Image size 2212x1659 — 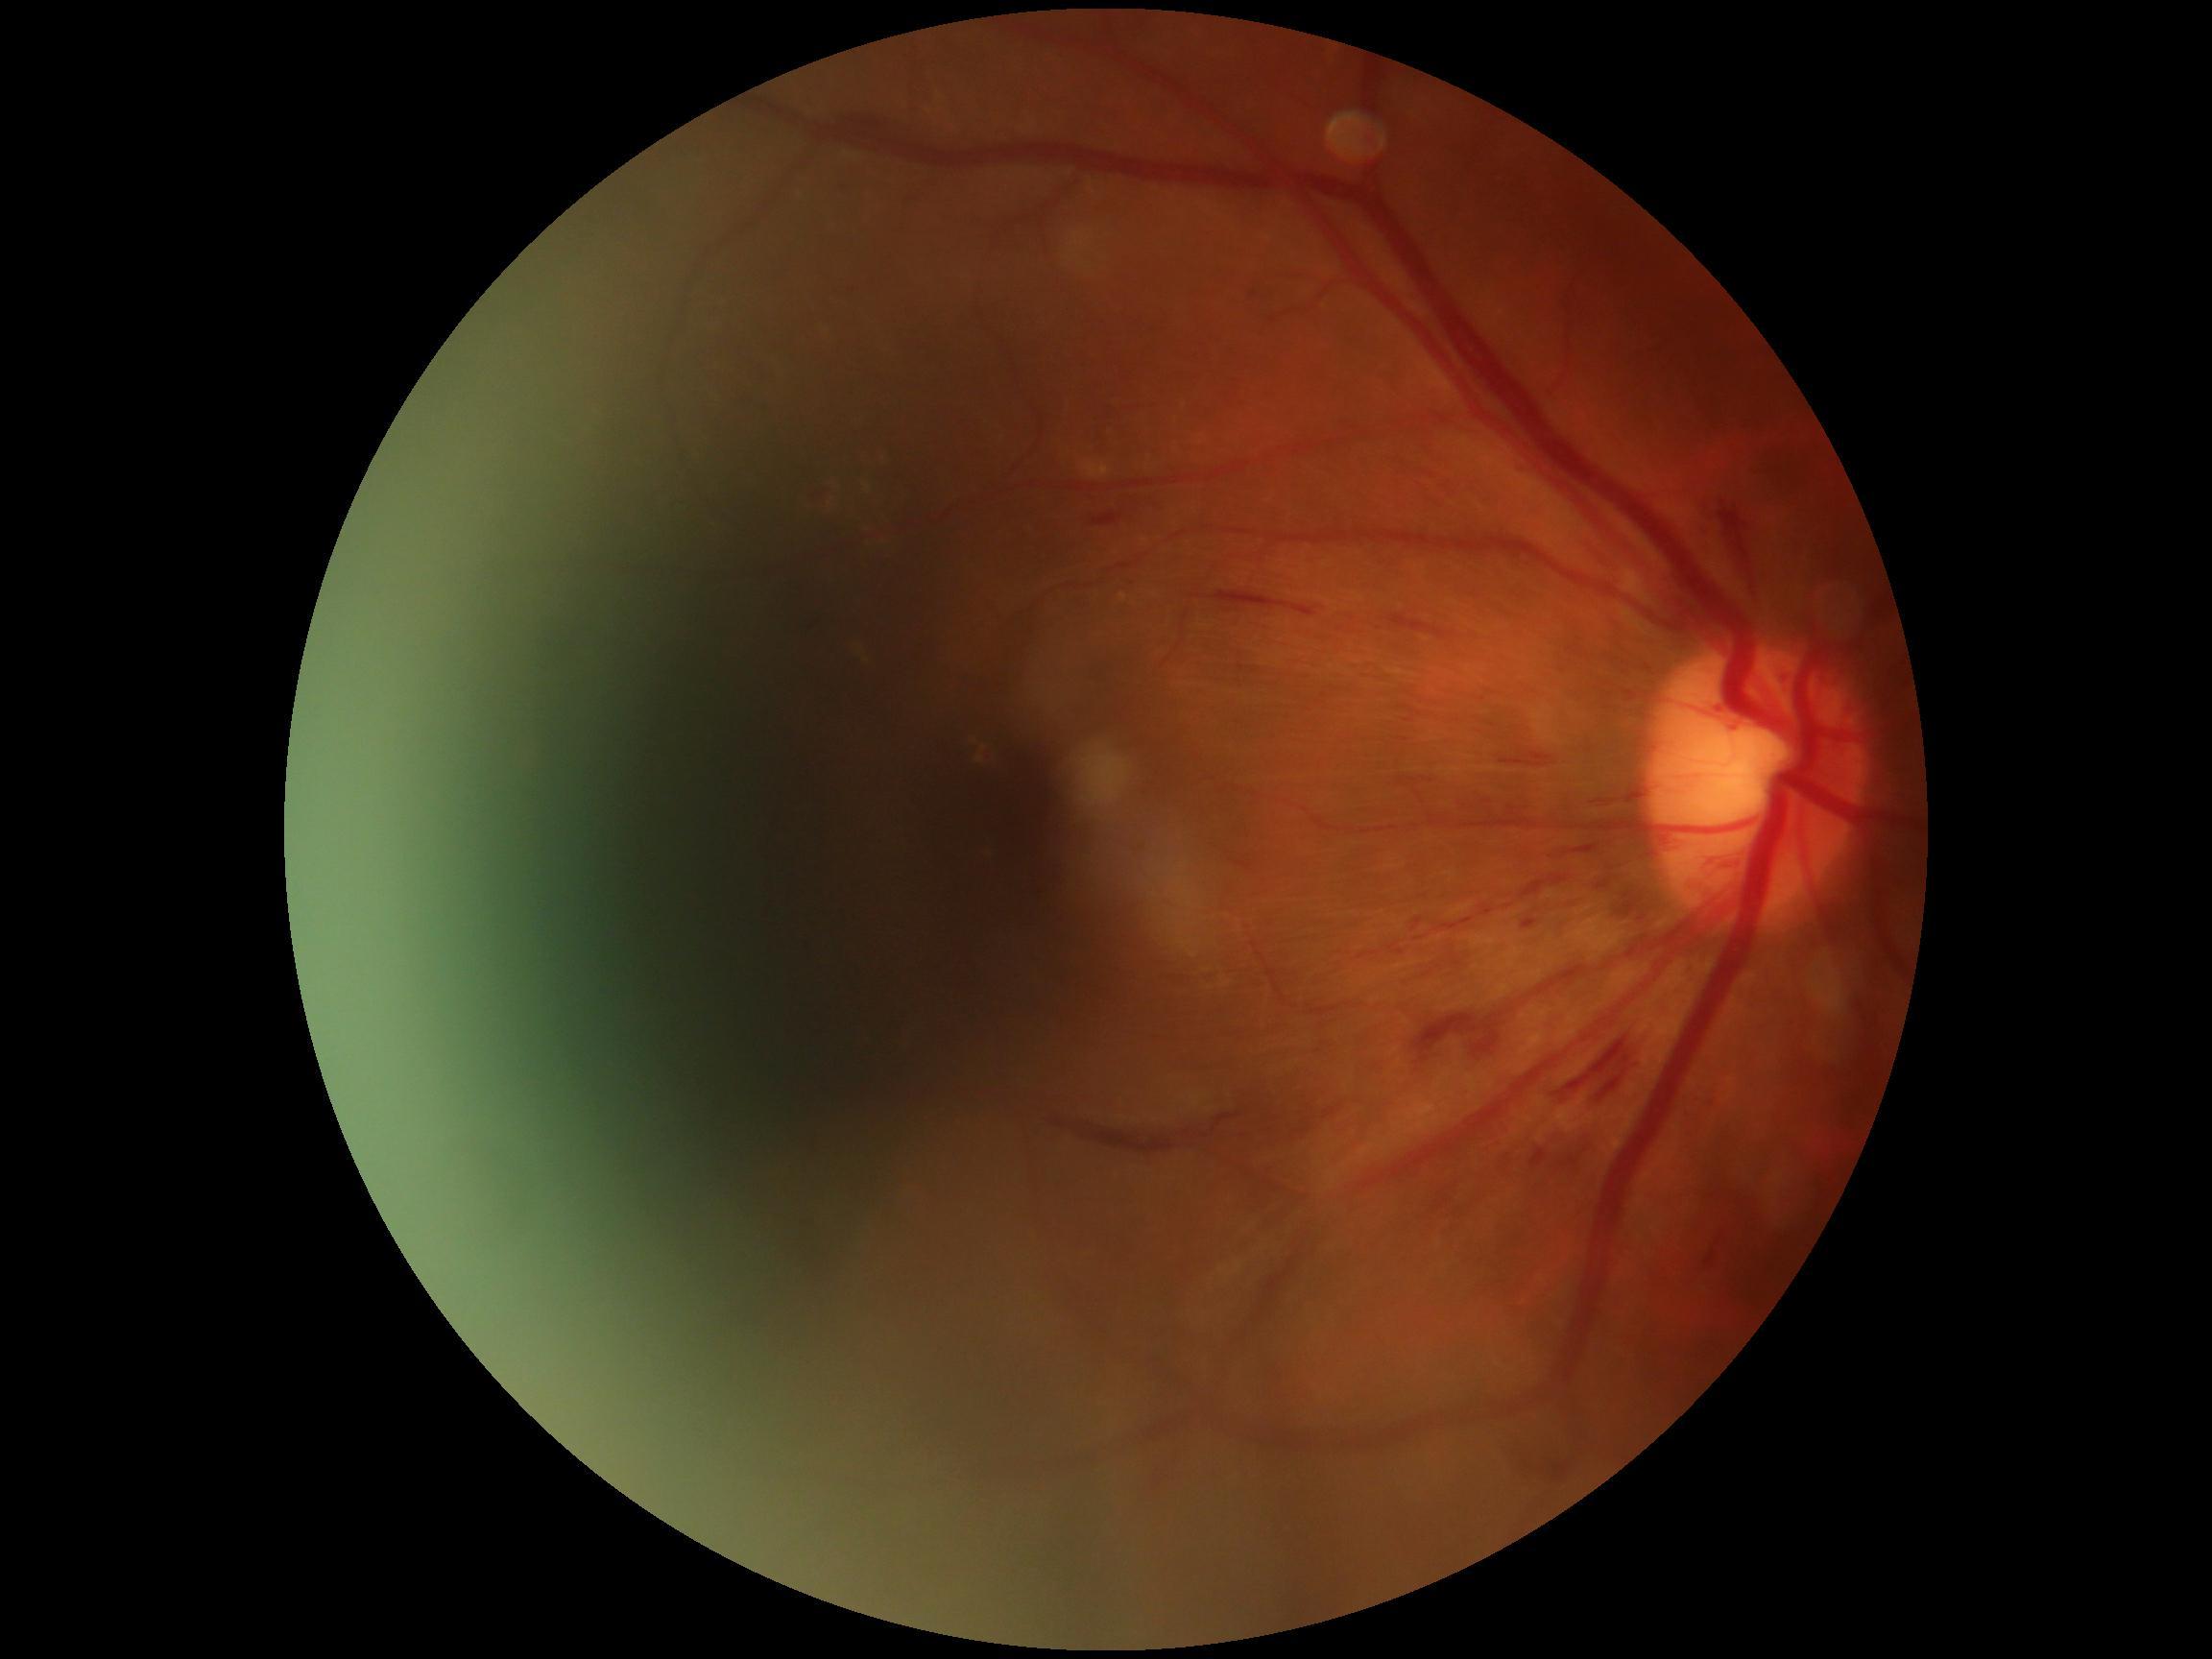

Diabetic retinopathy grade: 2 (moderate NPDR).